Davis DR grading. Nonmydriatic — 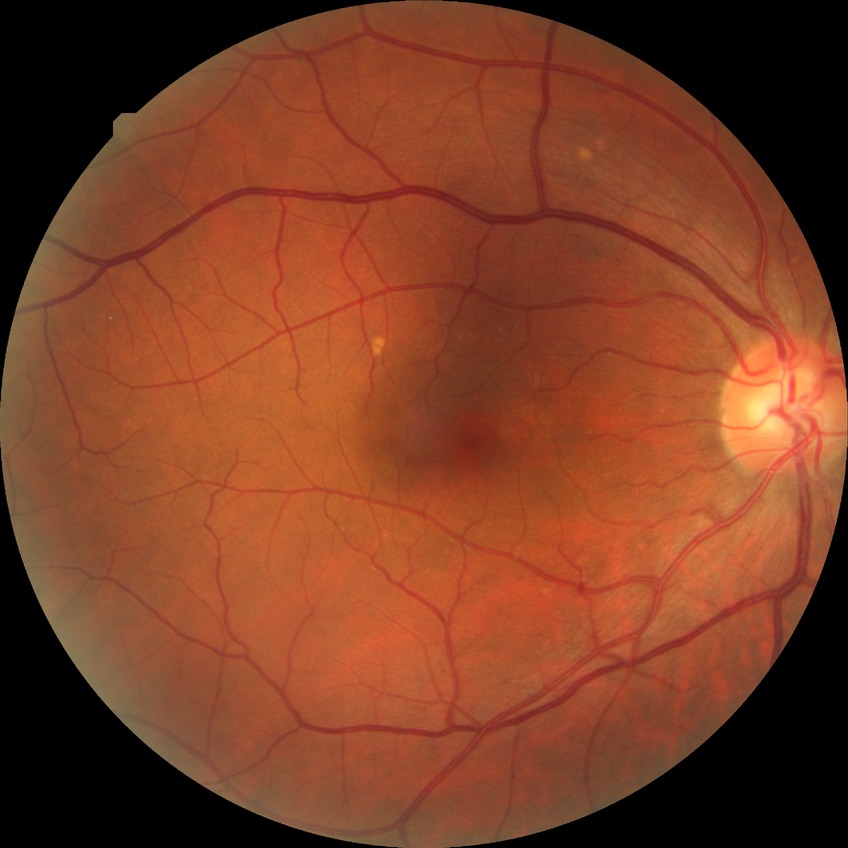

diabetic retinopathy stage: no diabetic retinopathy